Wide-field fundus photograph from neonatal ROP screening; captured with the Clarity RetCam 3 (130° field of view): 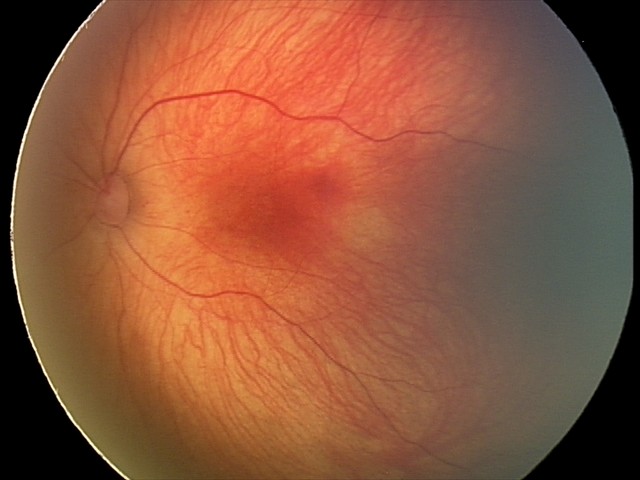

Examination diagnosed as retinal hemorrhages.